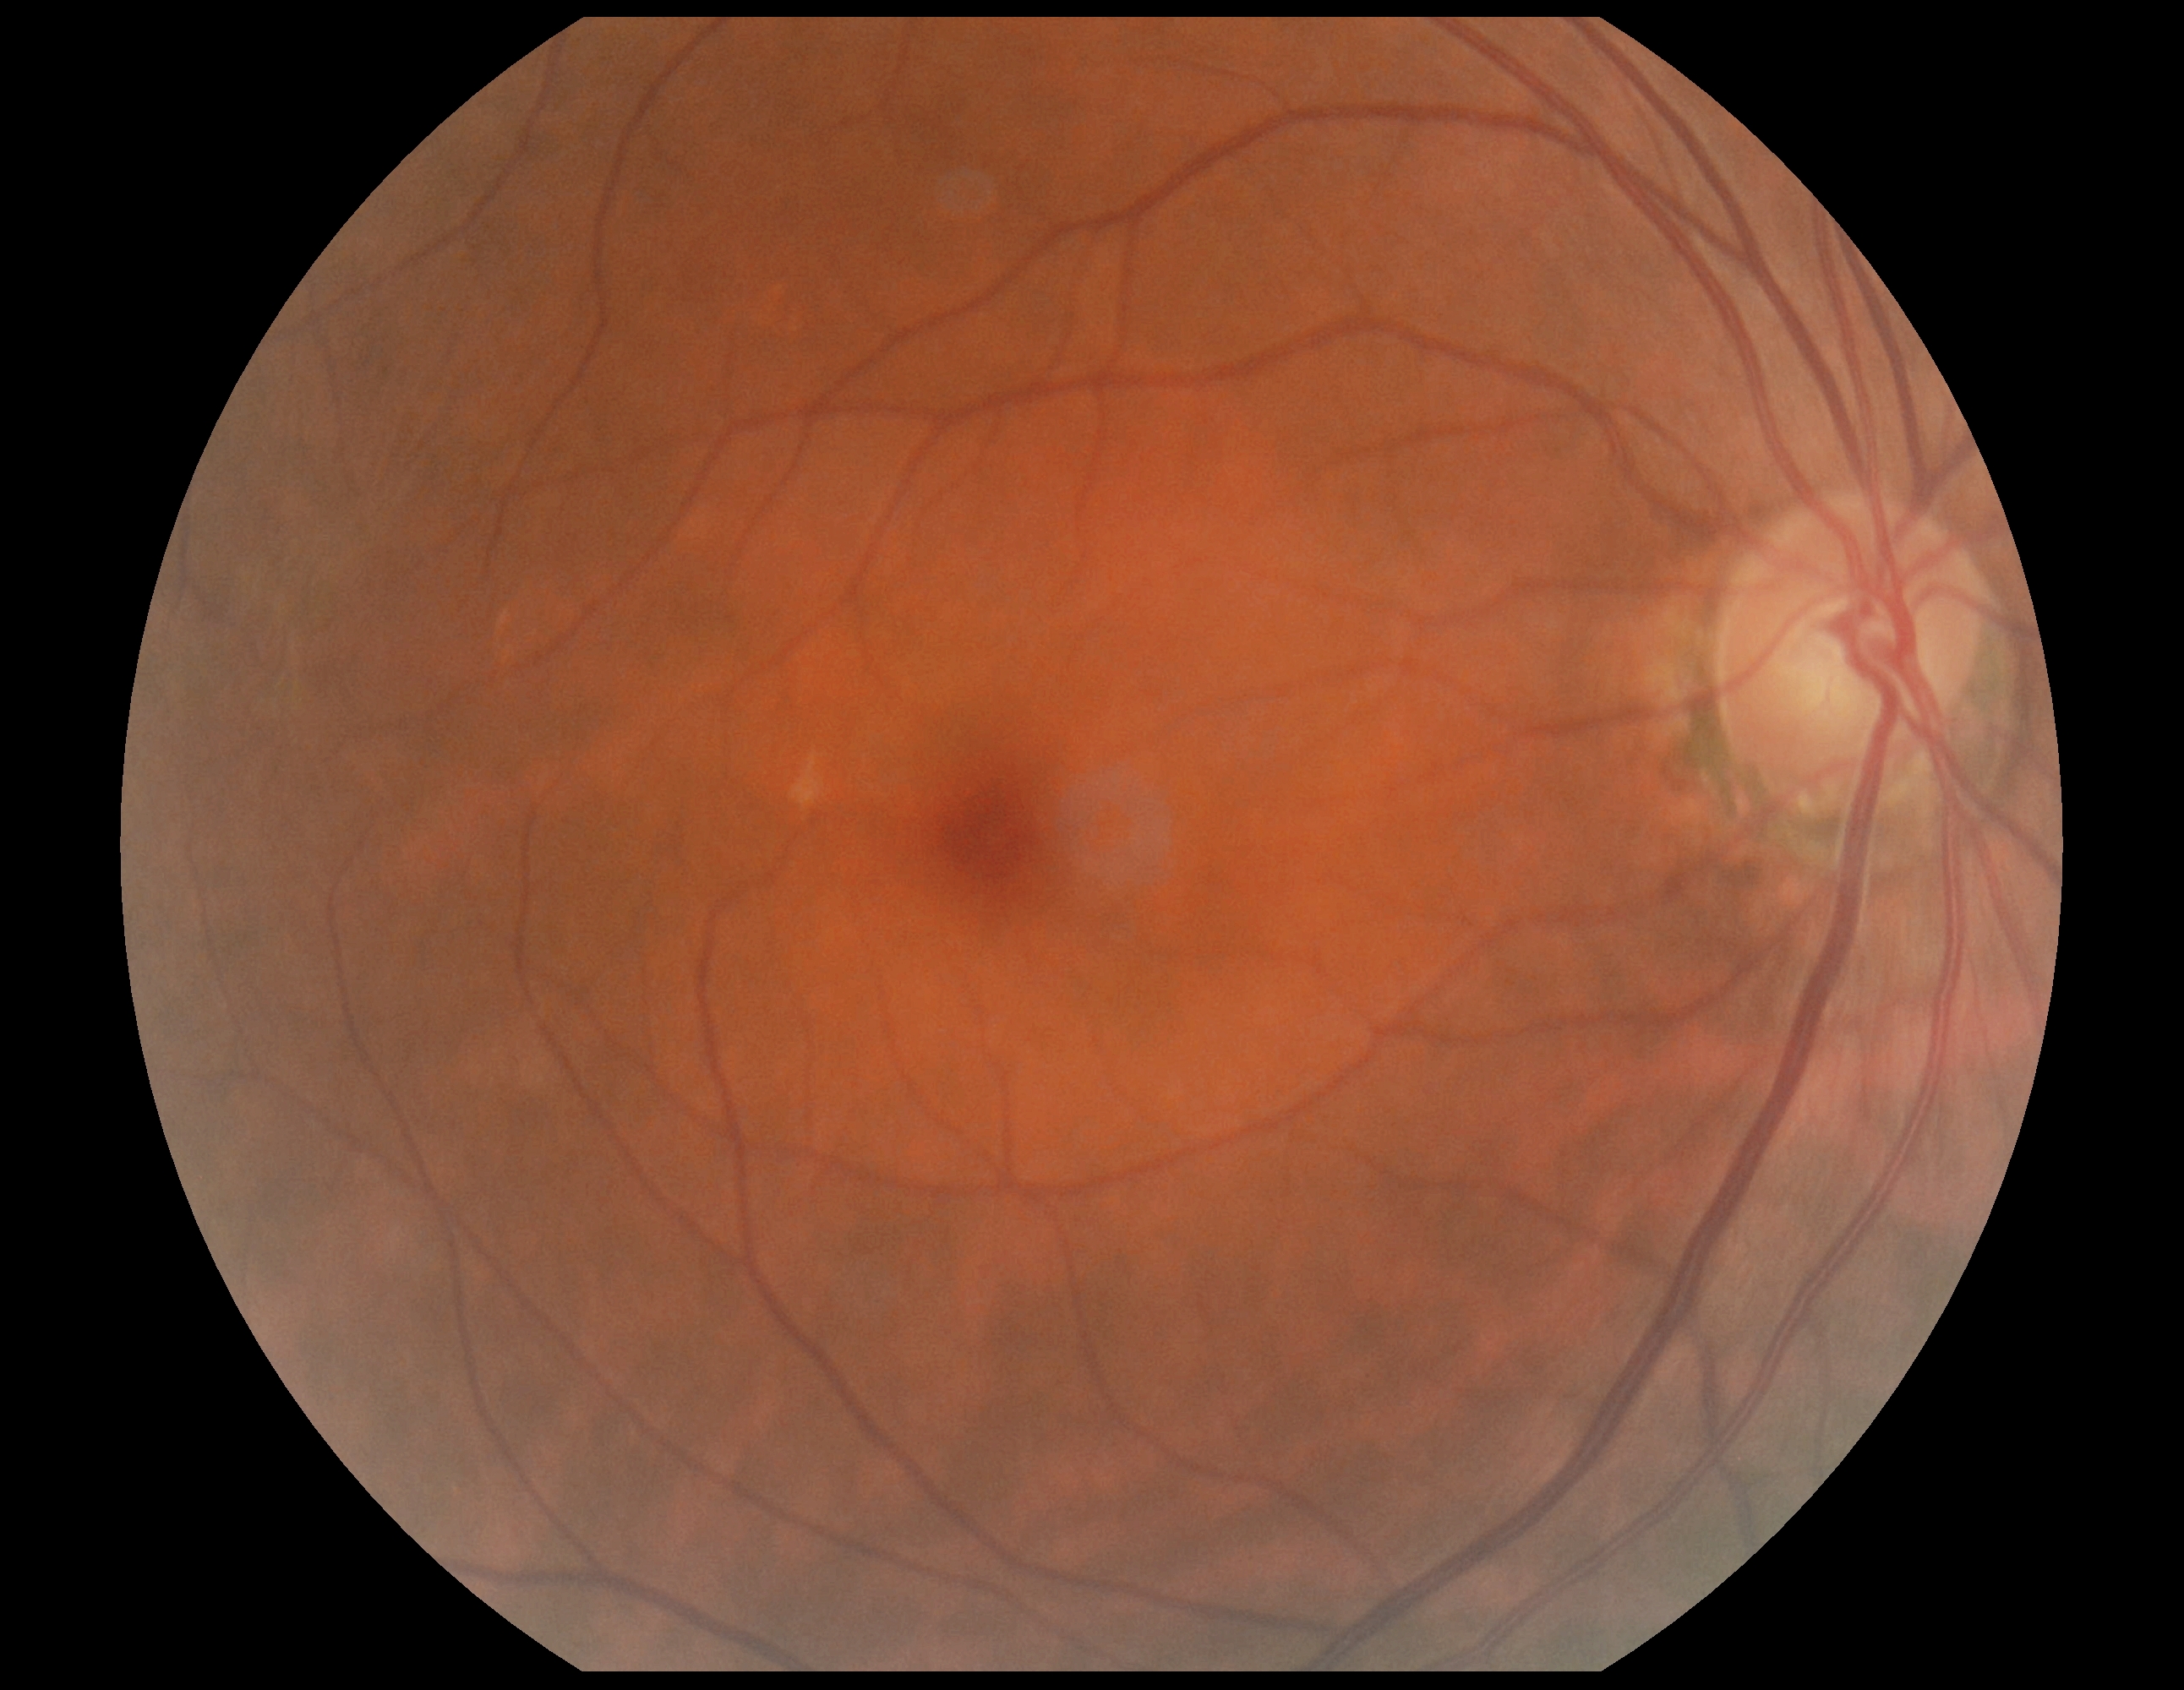
DR grade is 0.